Color fundus image, image size 512x512.
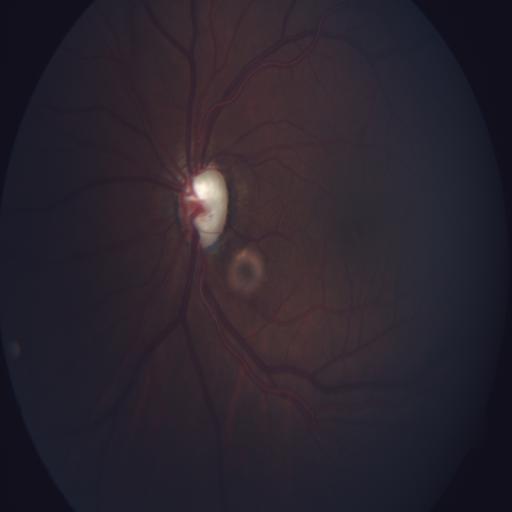
Impression: ODC (optic disc cupping).